45-degree field of view:
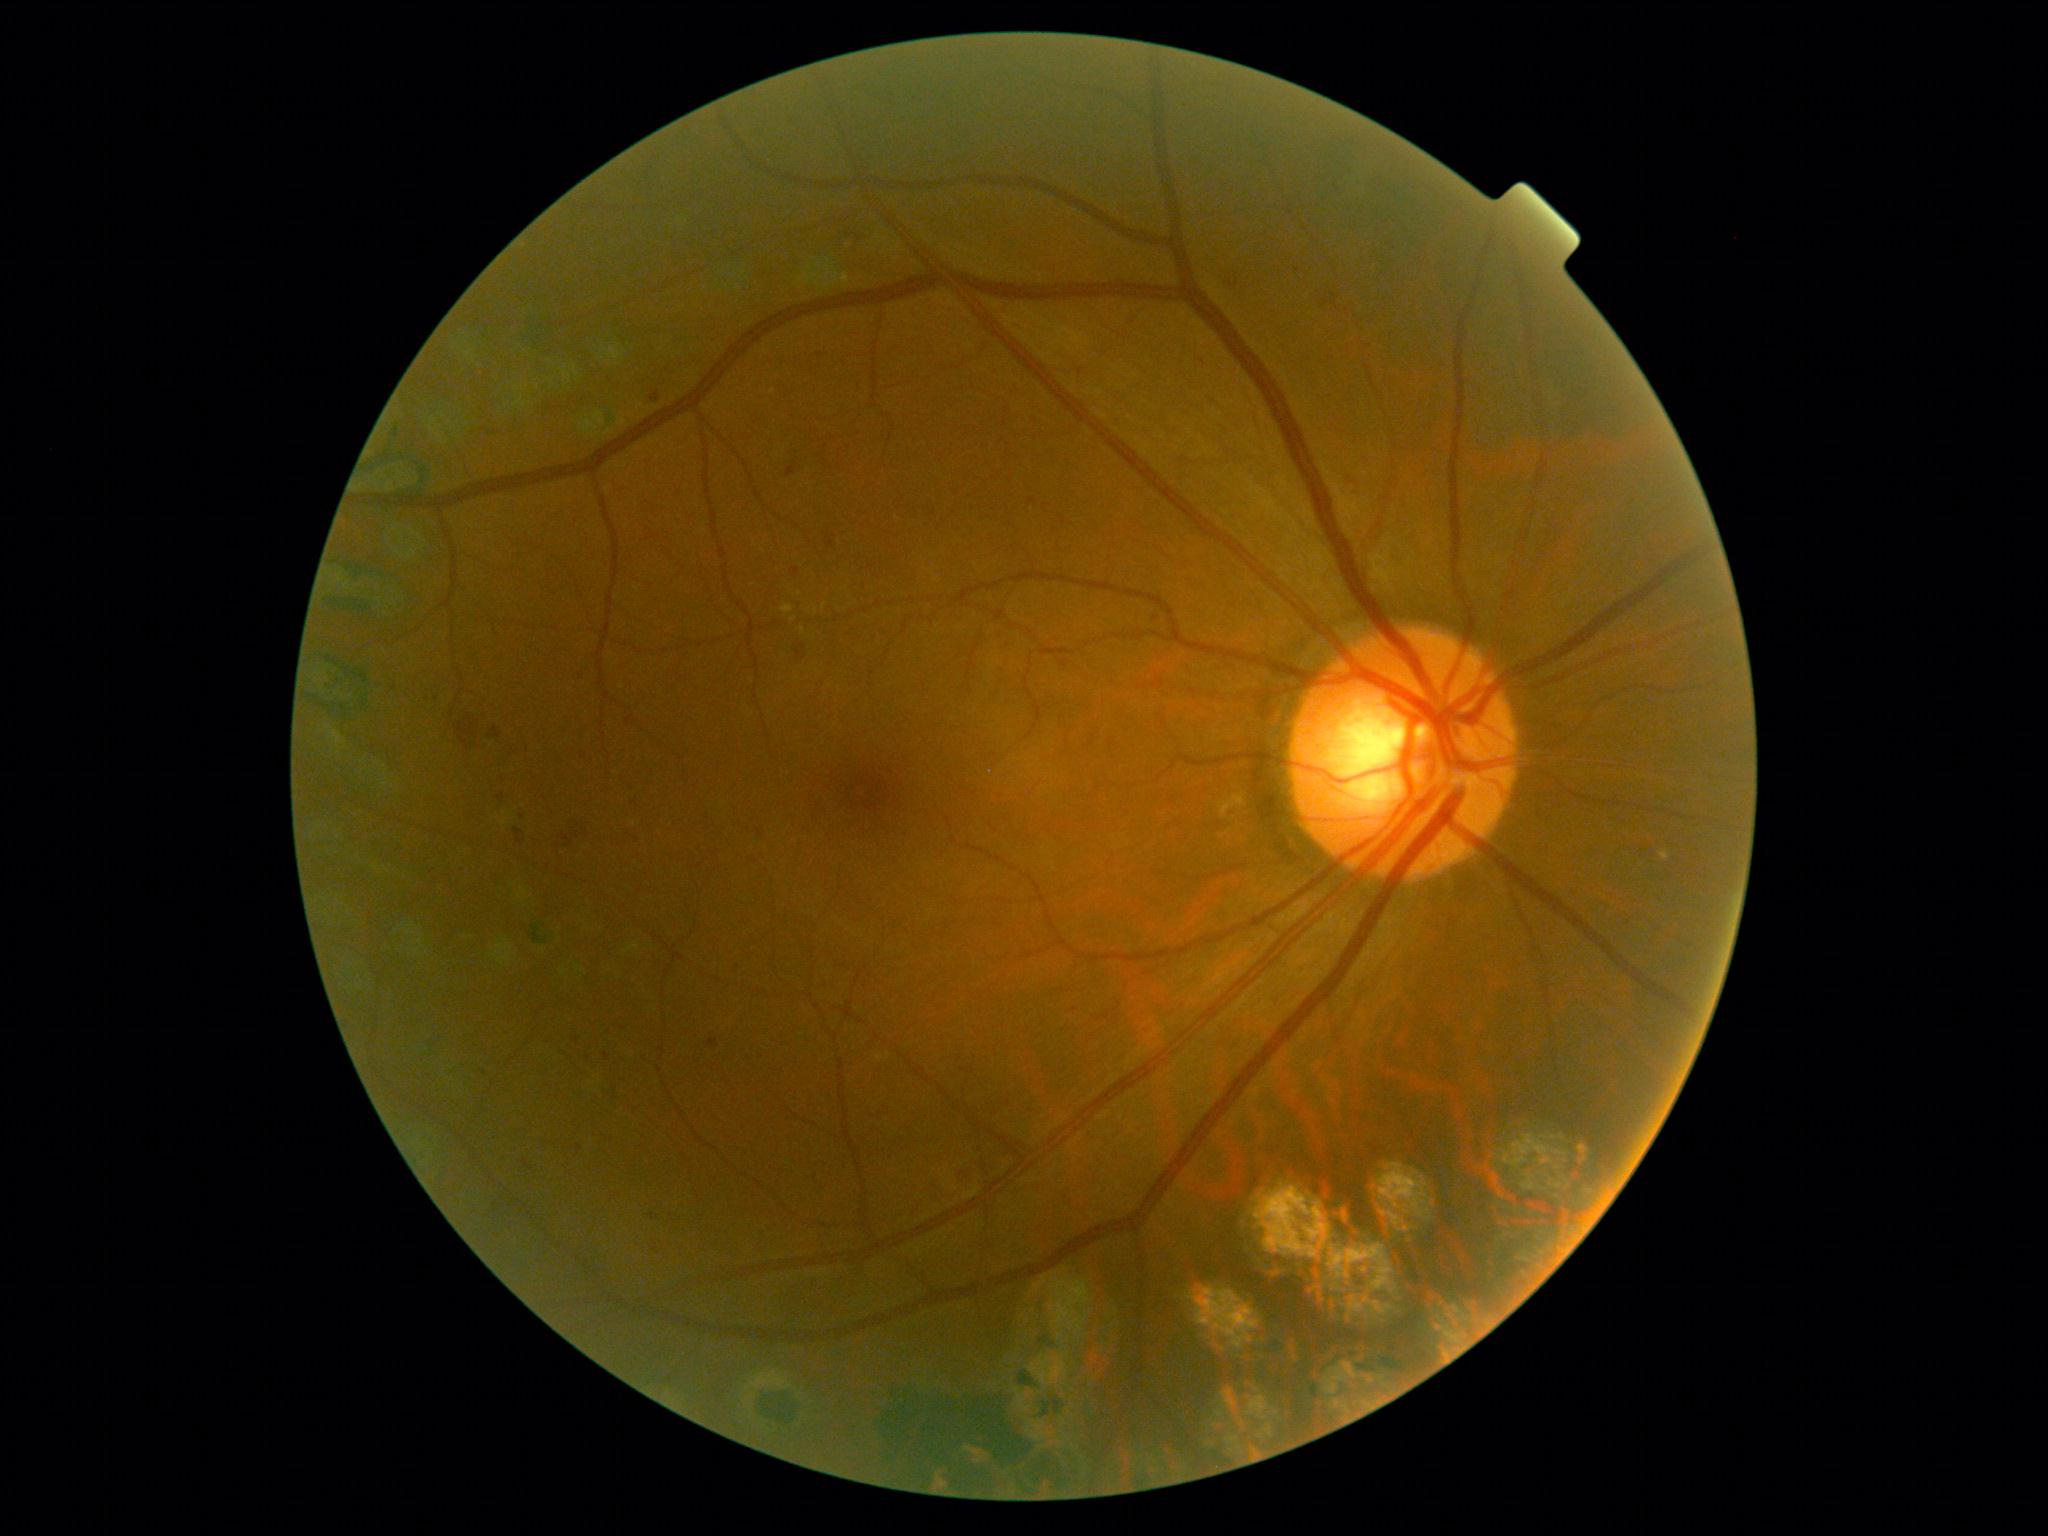

DR = grade 2 (moderate NPDR) — more than just microaneurysms but less than severe NPDR.